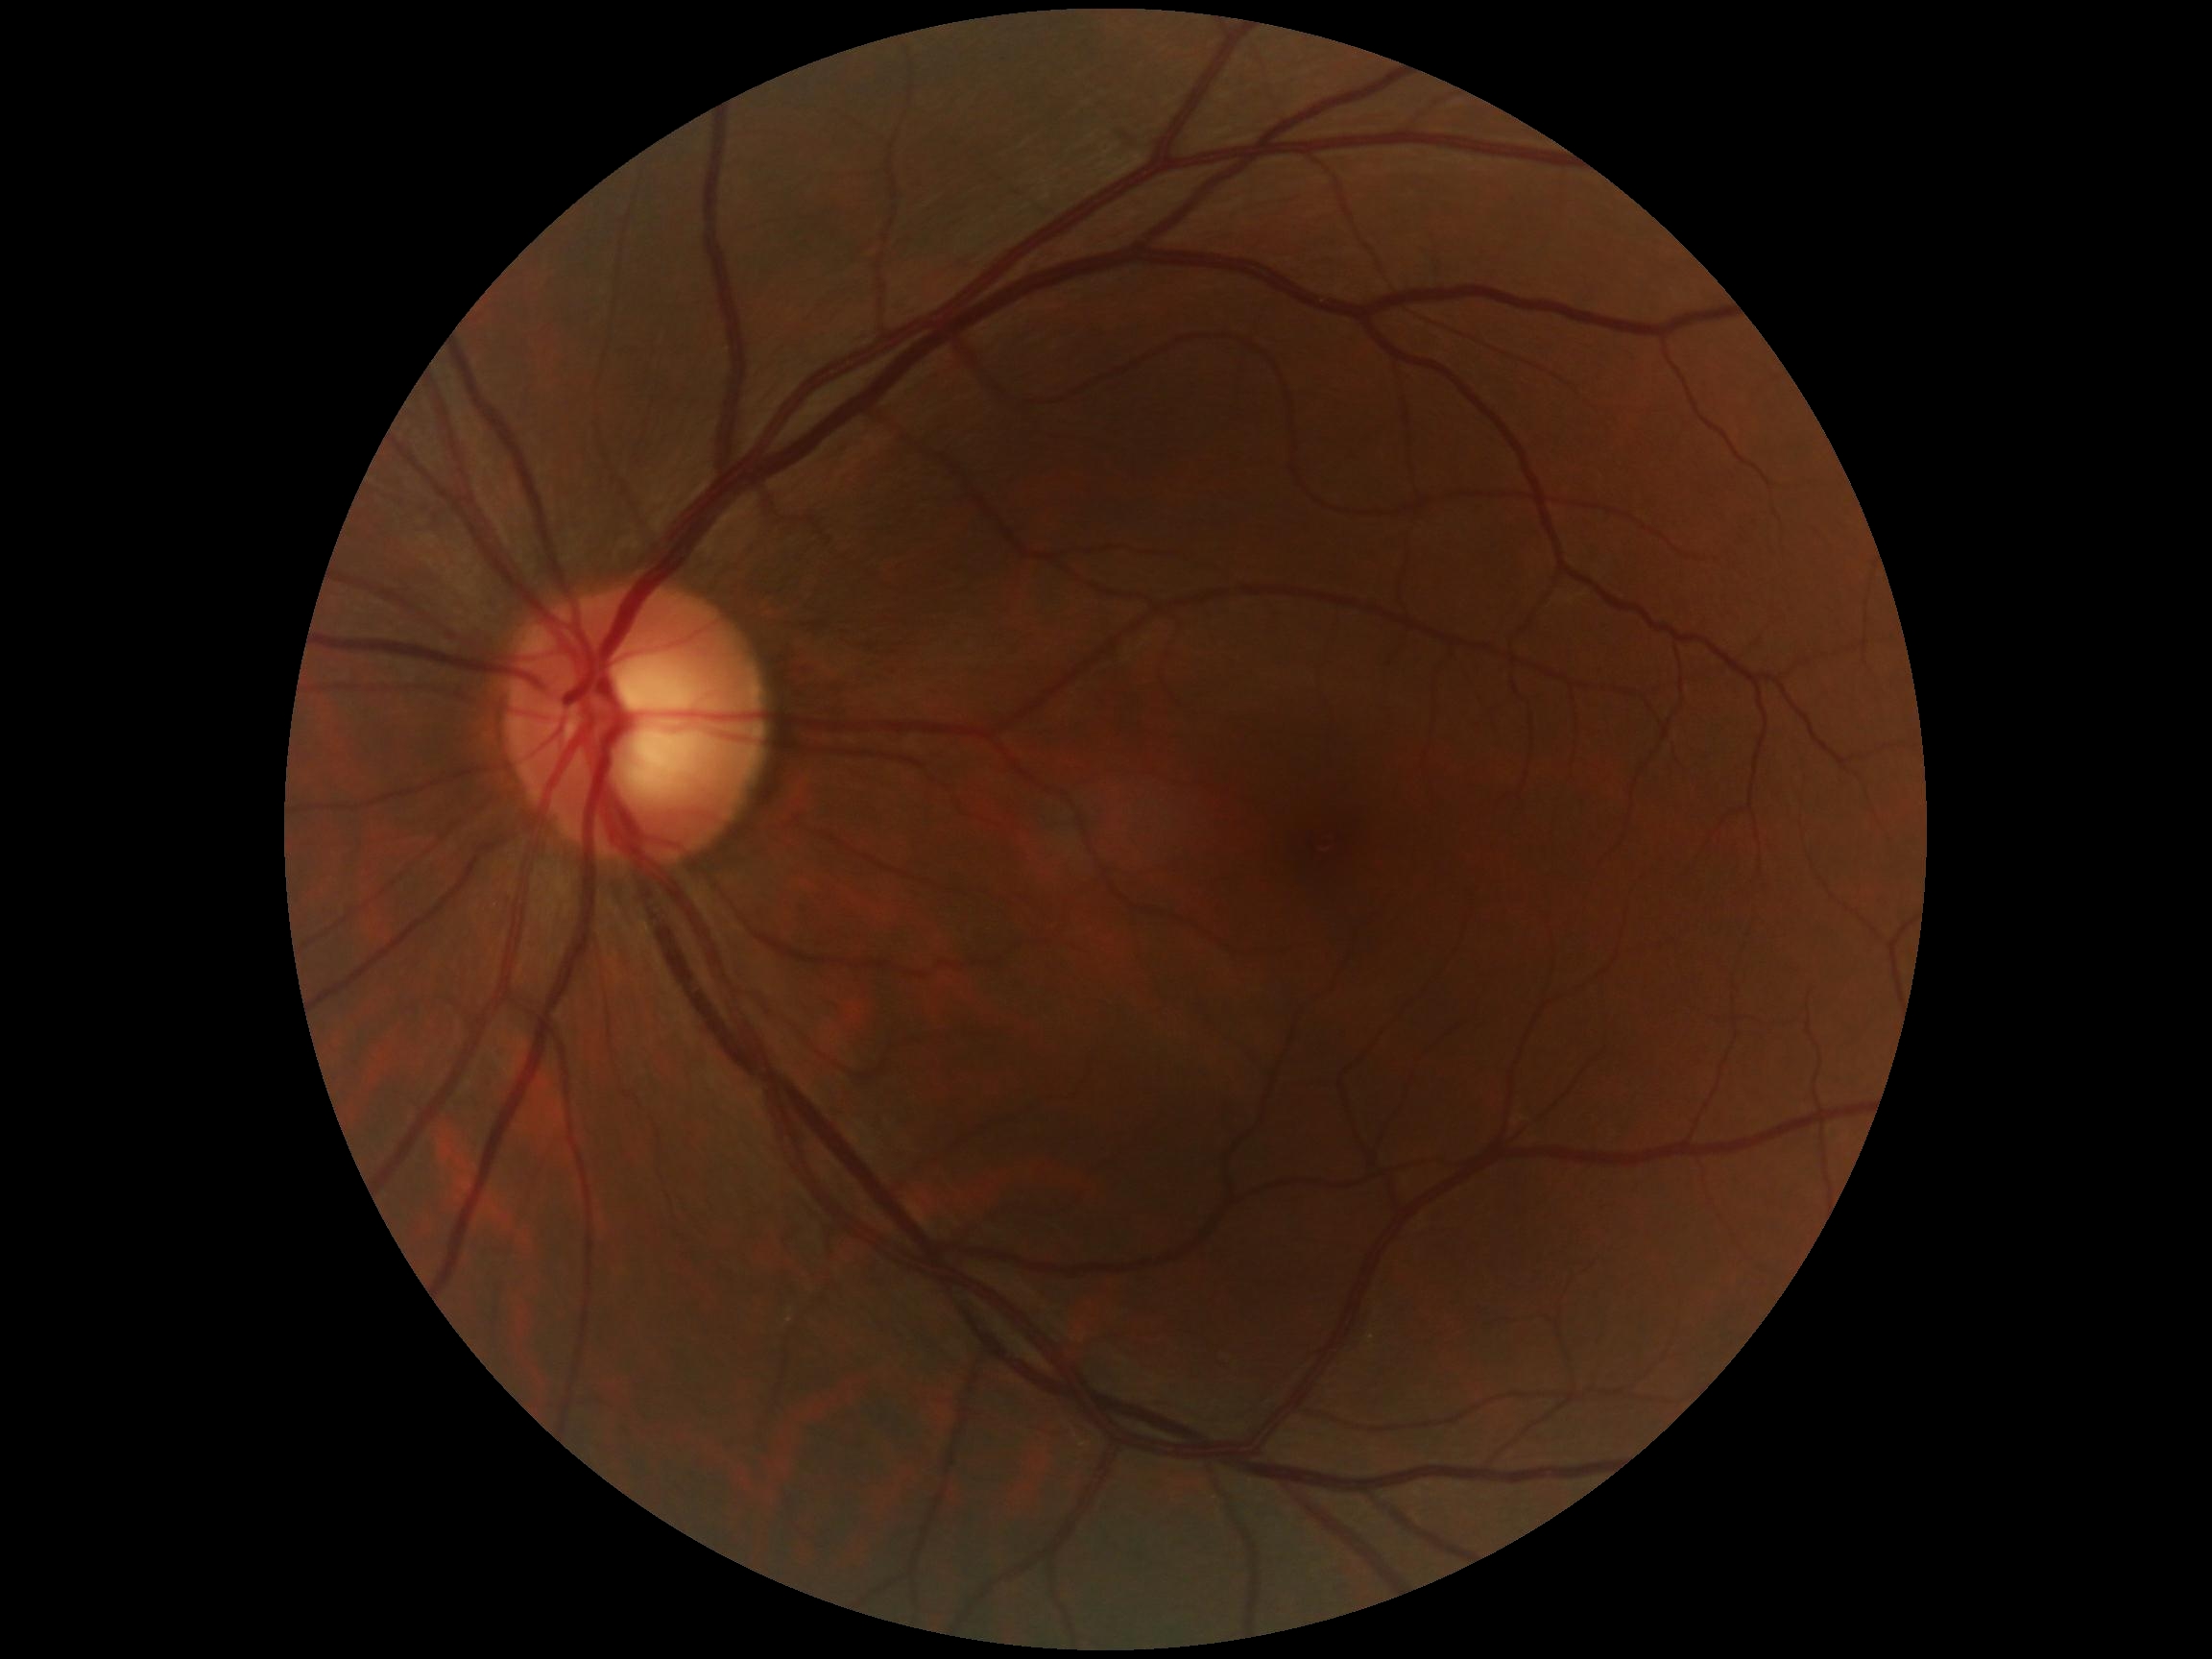

Retinopathy is grade 0.